Camera: Remidio Fundus on Phone (FOP) camera:
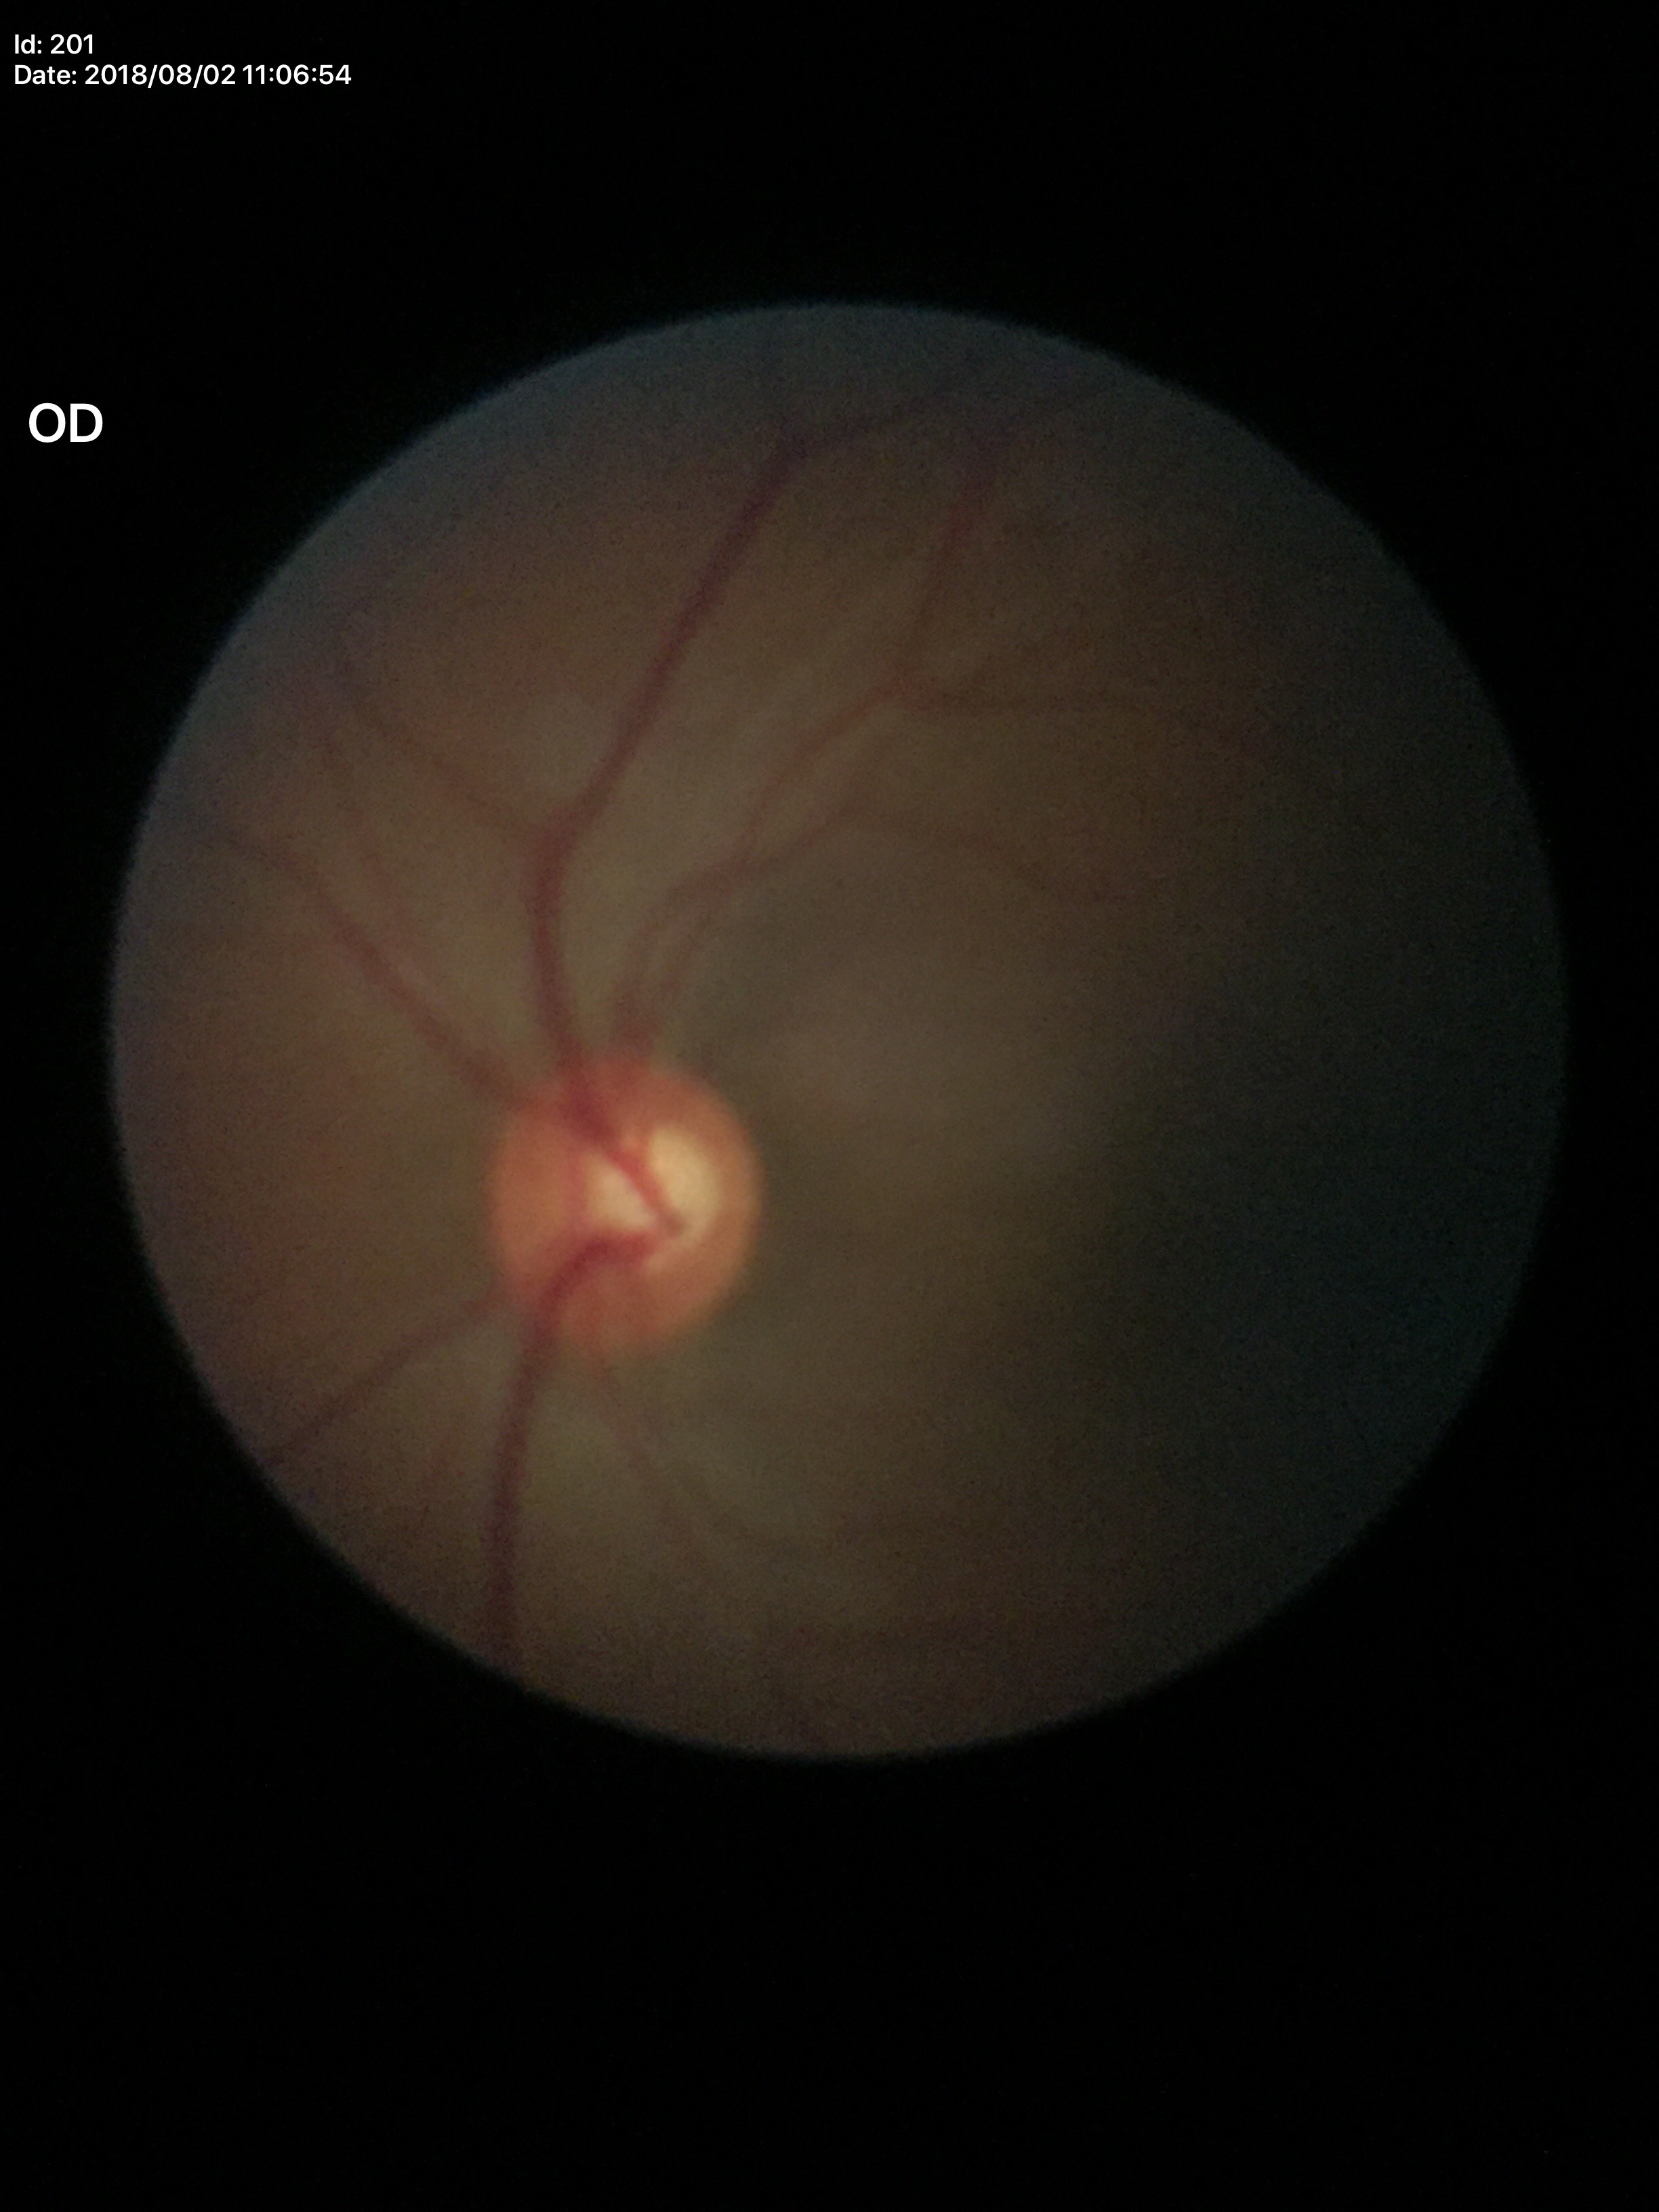 VCDR of 0.54.
Glaucoma evaluation: not suspect (all 5 graders called normal).